848 x 848 pixels; without pupil dilation: 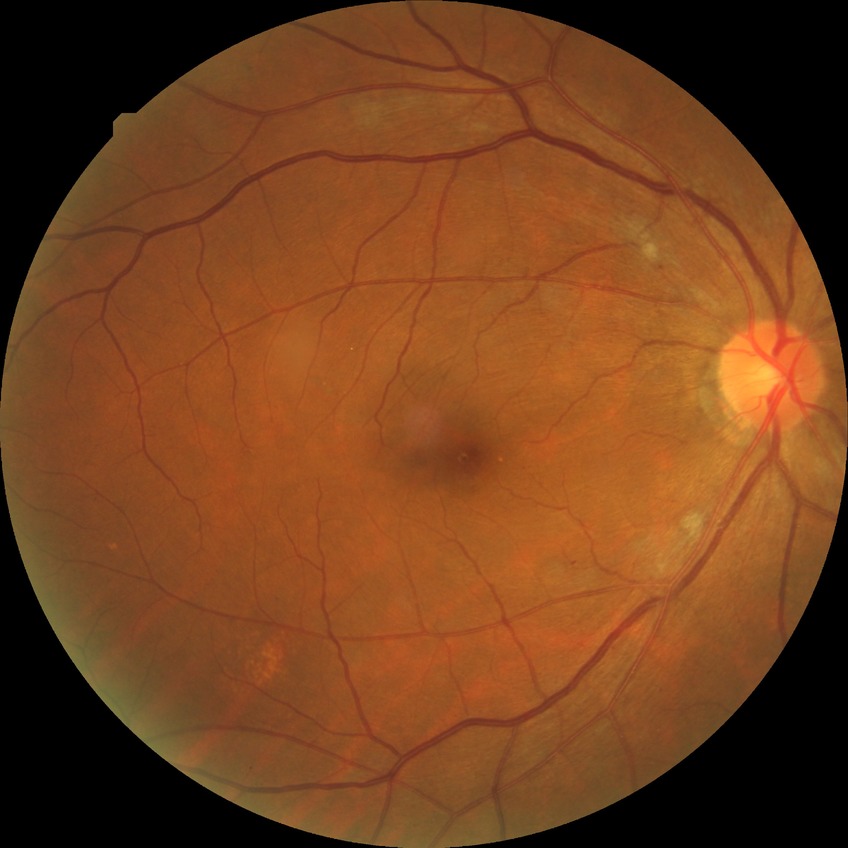 Diabetic retinopathy (DR): PPDR (pre-proliferative diabetic retinopathy).